Captured on a Remidio Fundus on Phone (FOP) camera, fundus photo:
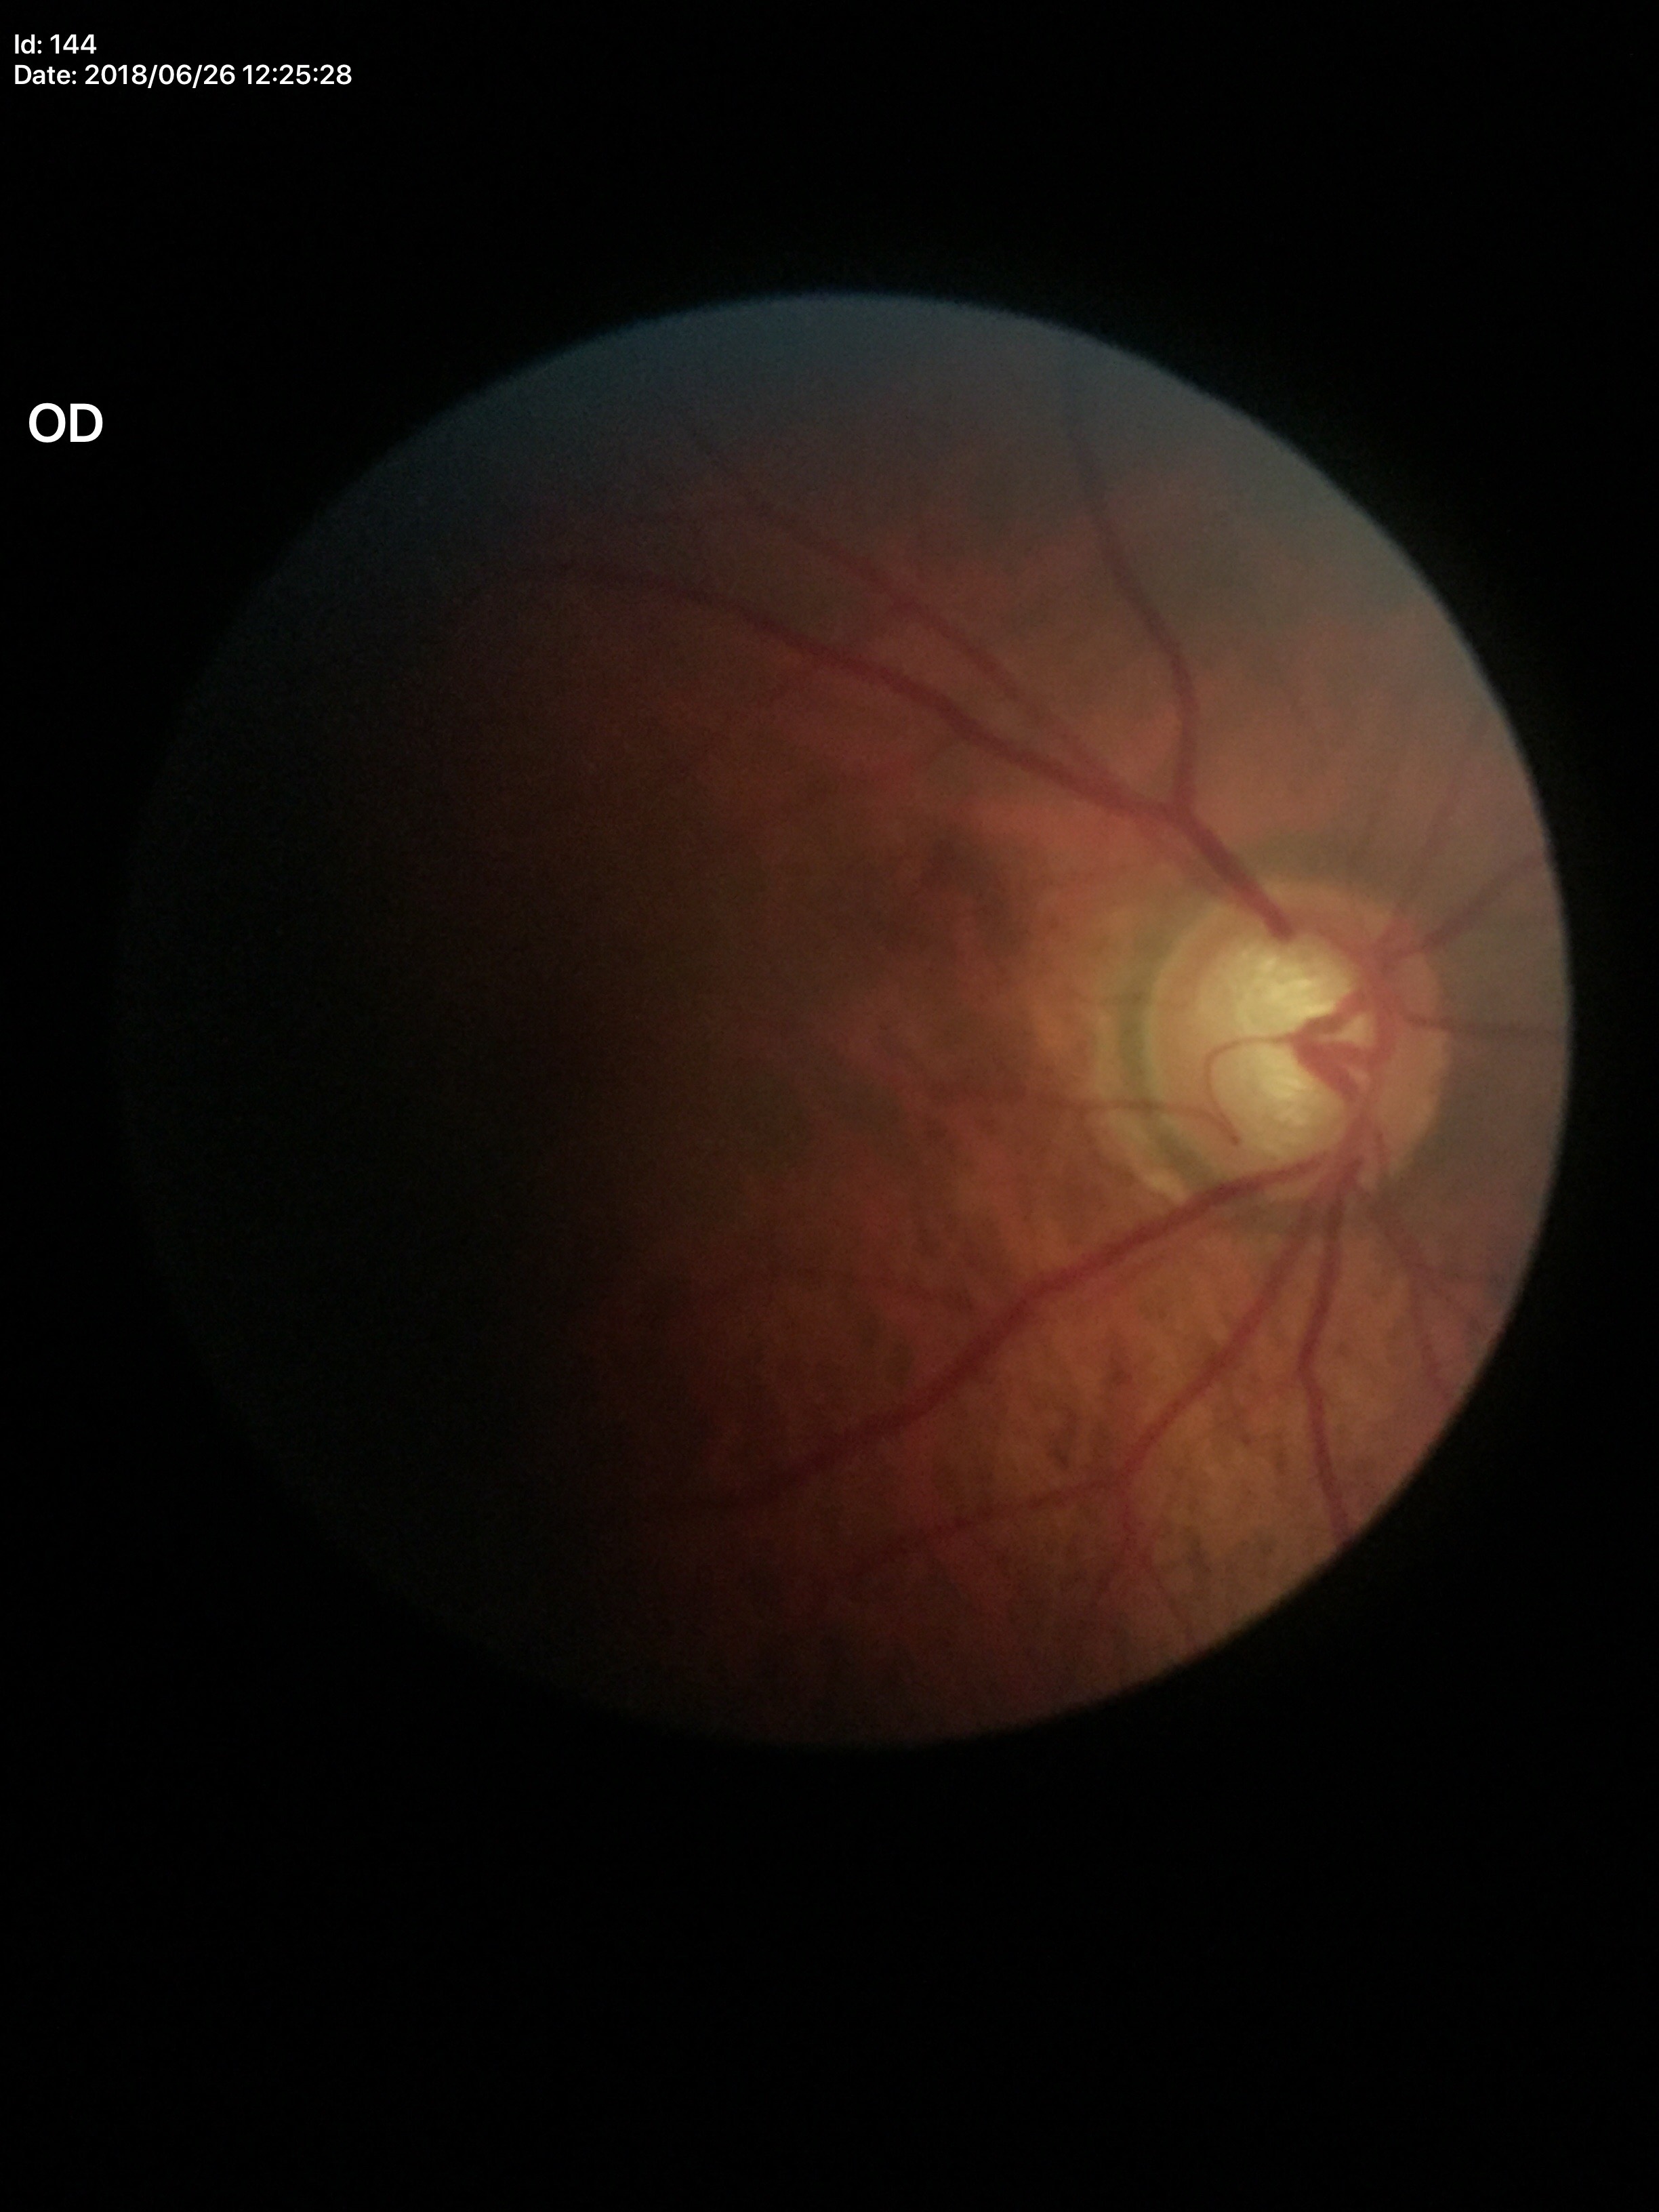

vcdr: 0.76
glaucoma_decision: suspect (unanimous glaucoma-suspect call)
hcdr: 0.67